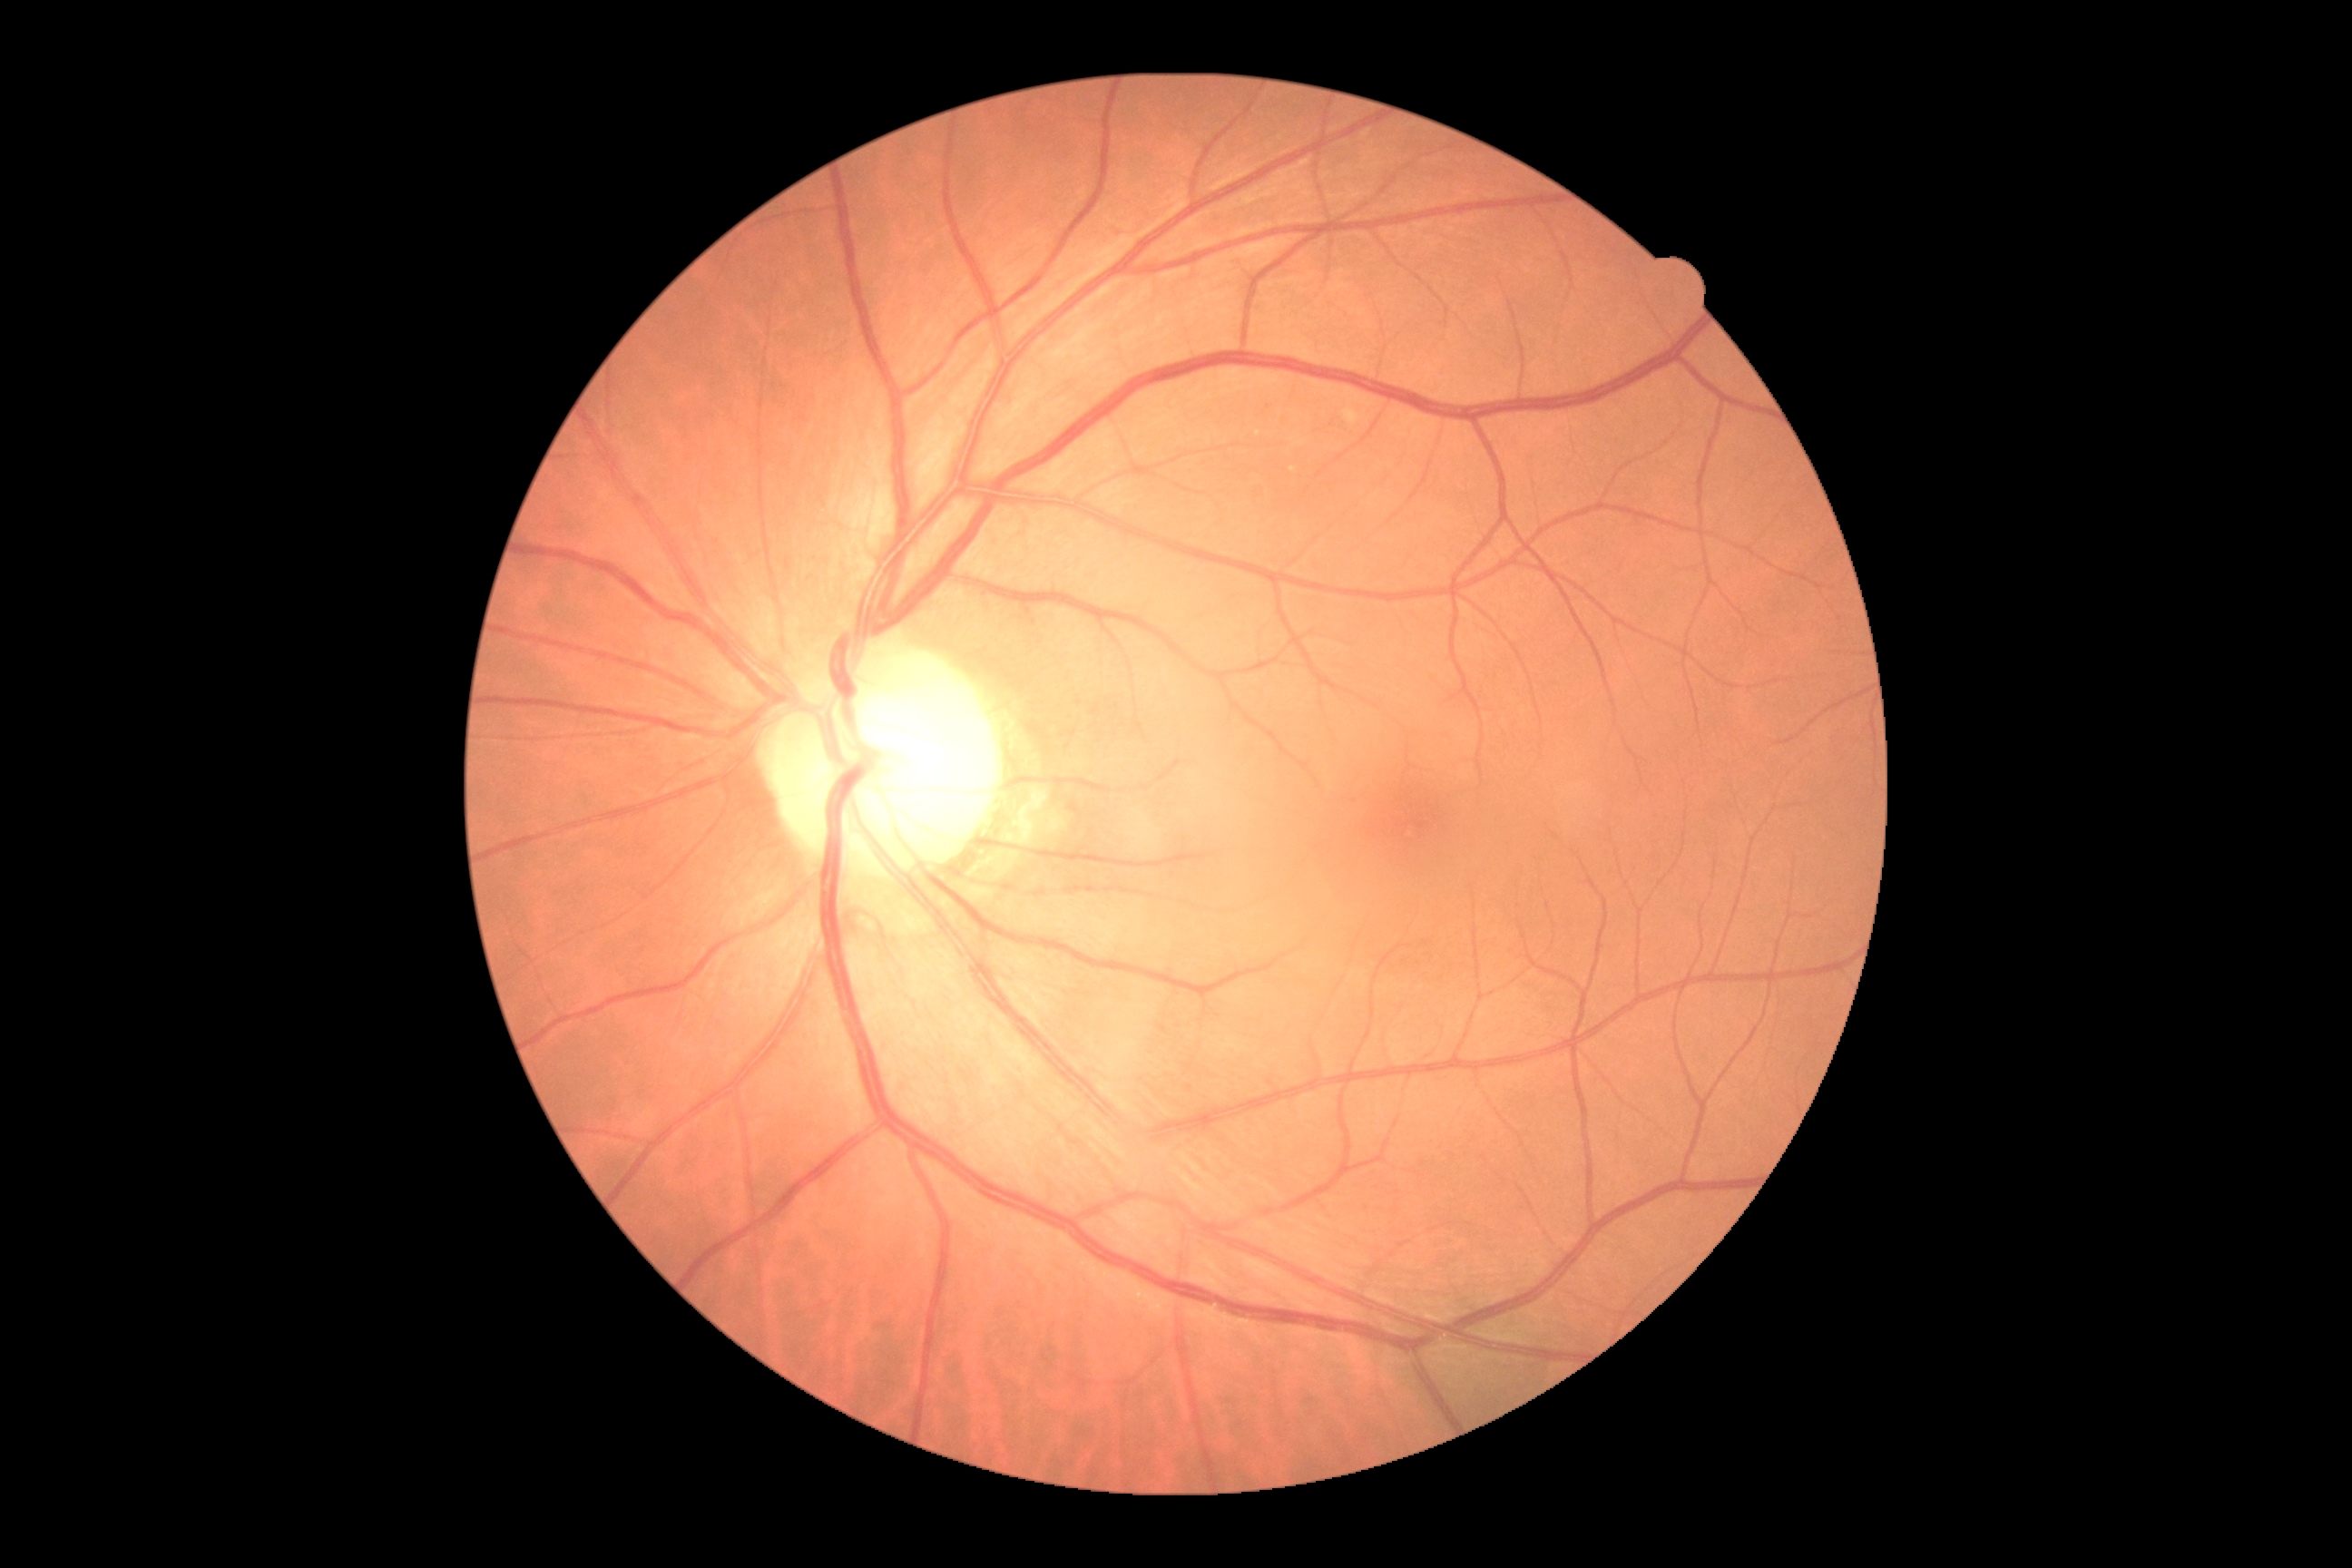
Diabetic retinopathy severity: grade 0 (no apparent retinopathy).